Nonmydriatic · NIDEK AFC-230 fundus camera · 848 x 848 pixels · CFP.
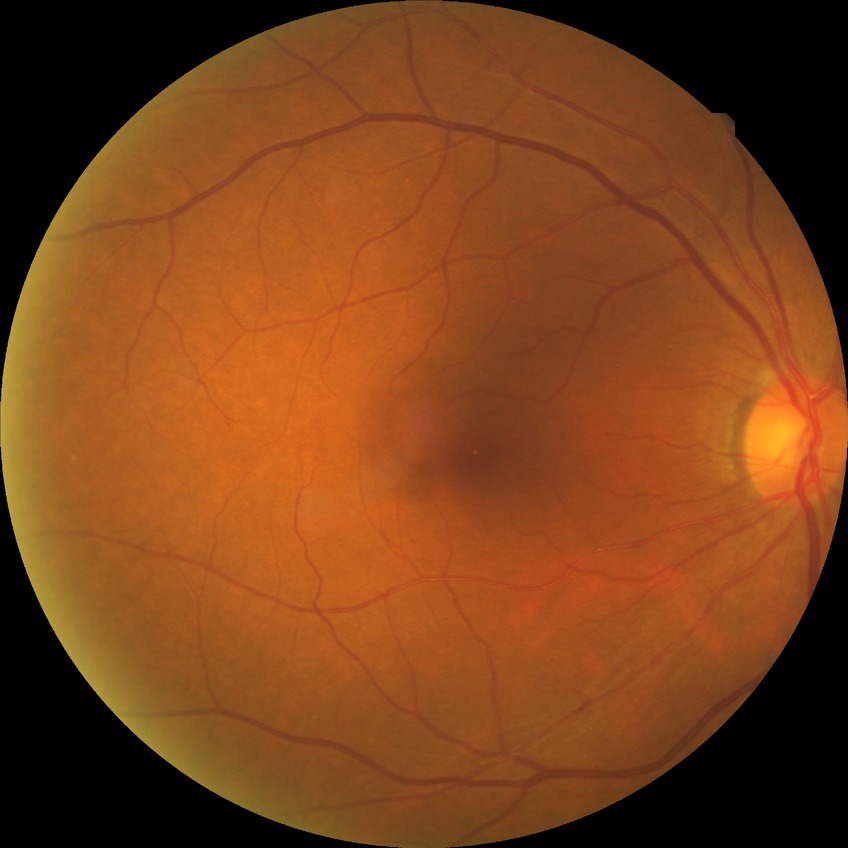 diabetic retinopathy (DR): no diabetic retinopathy (NDR)